DR severity per modified Davis staging: 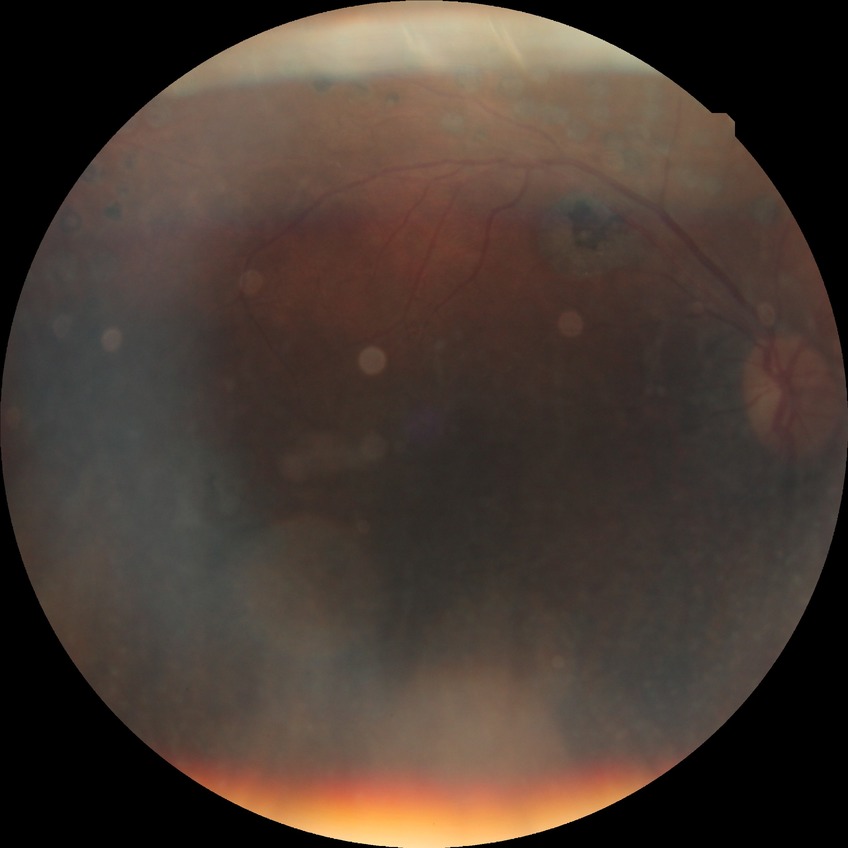 * diabetic retinopathy (DR) — PDR (proliferative diabetic retinopathy)